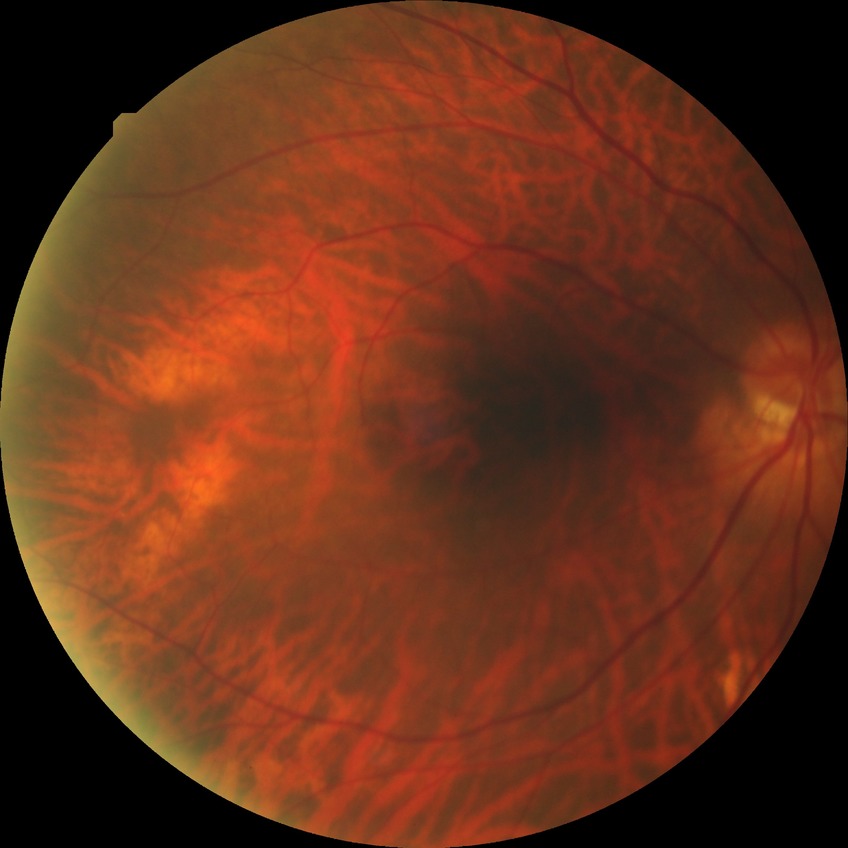
Diabetic retinopathy (DR): NDR (no diabetic retinopathy).